FOV: 45 degrees:
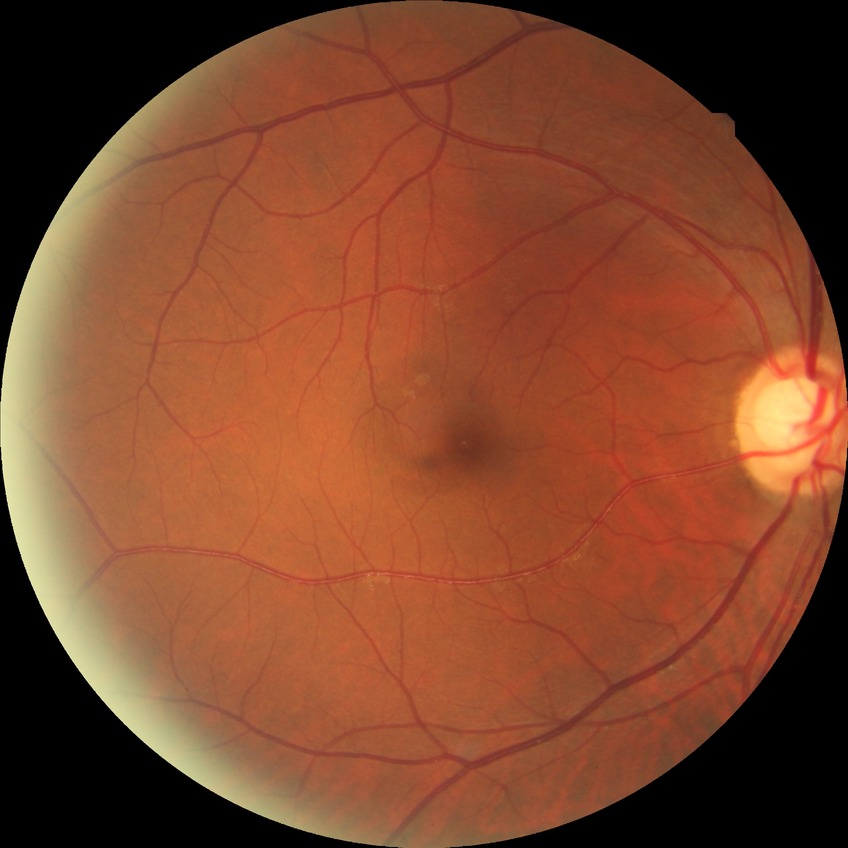
retinopathy stage@no diabetic retinopathy.